CFP: 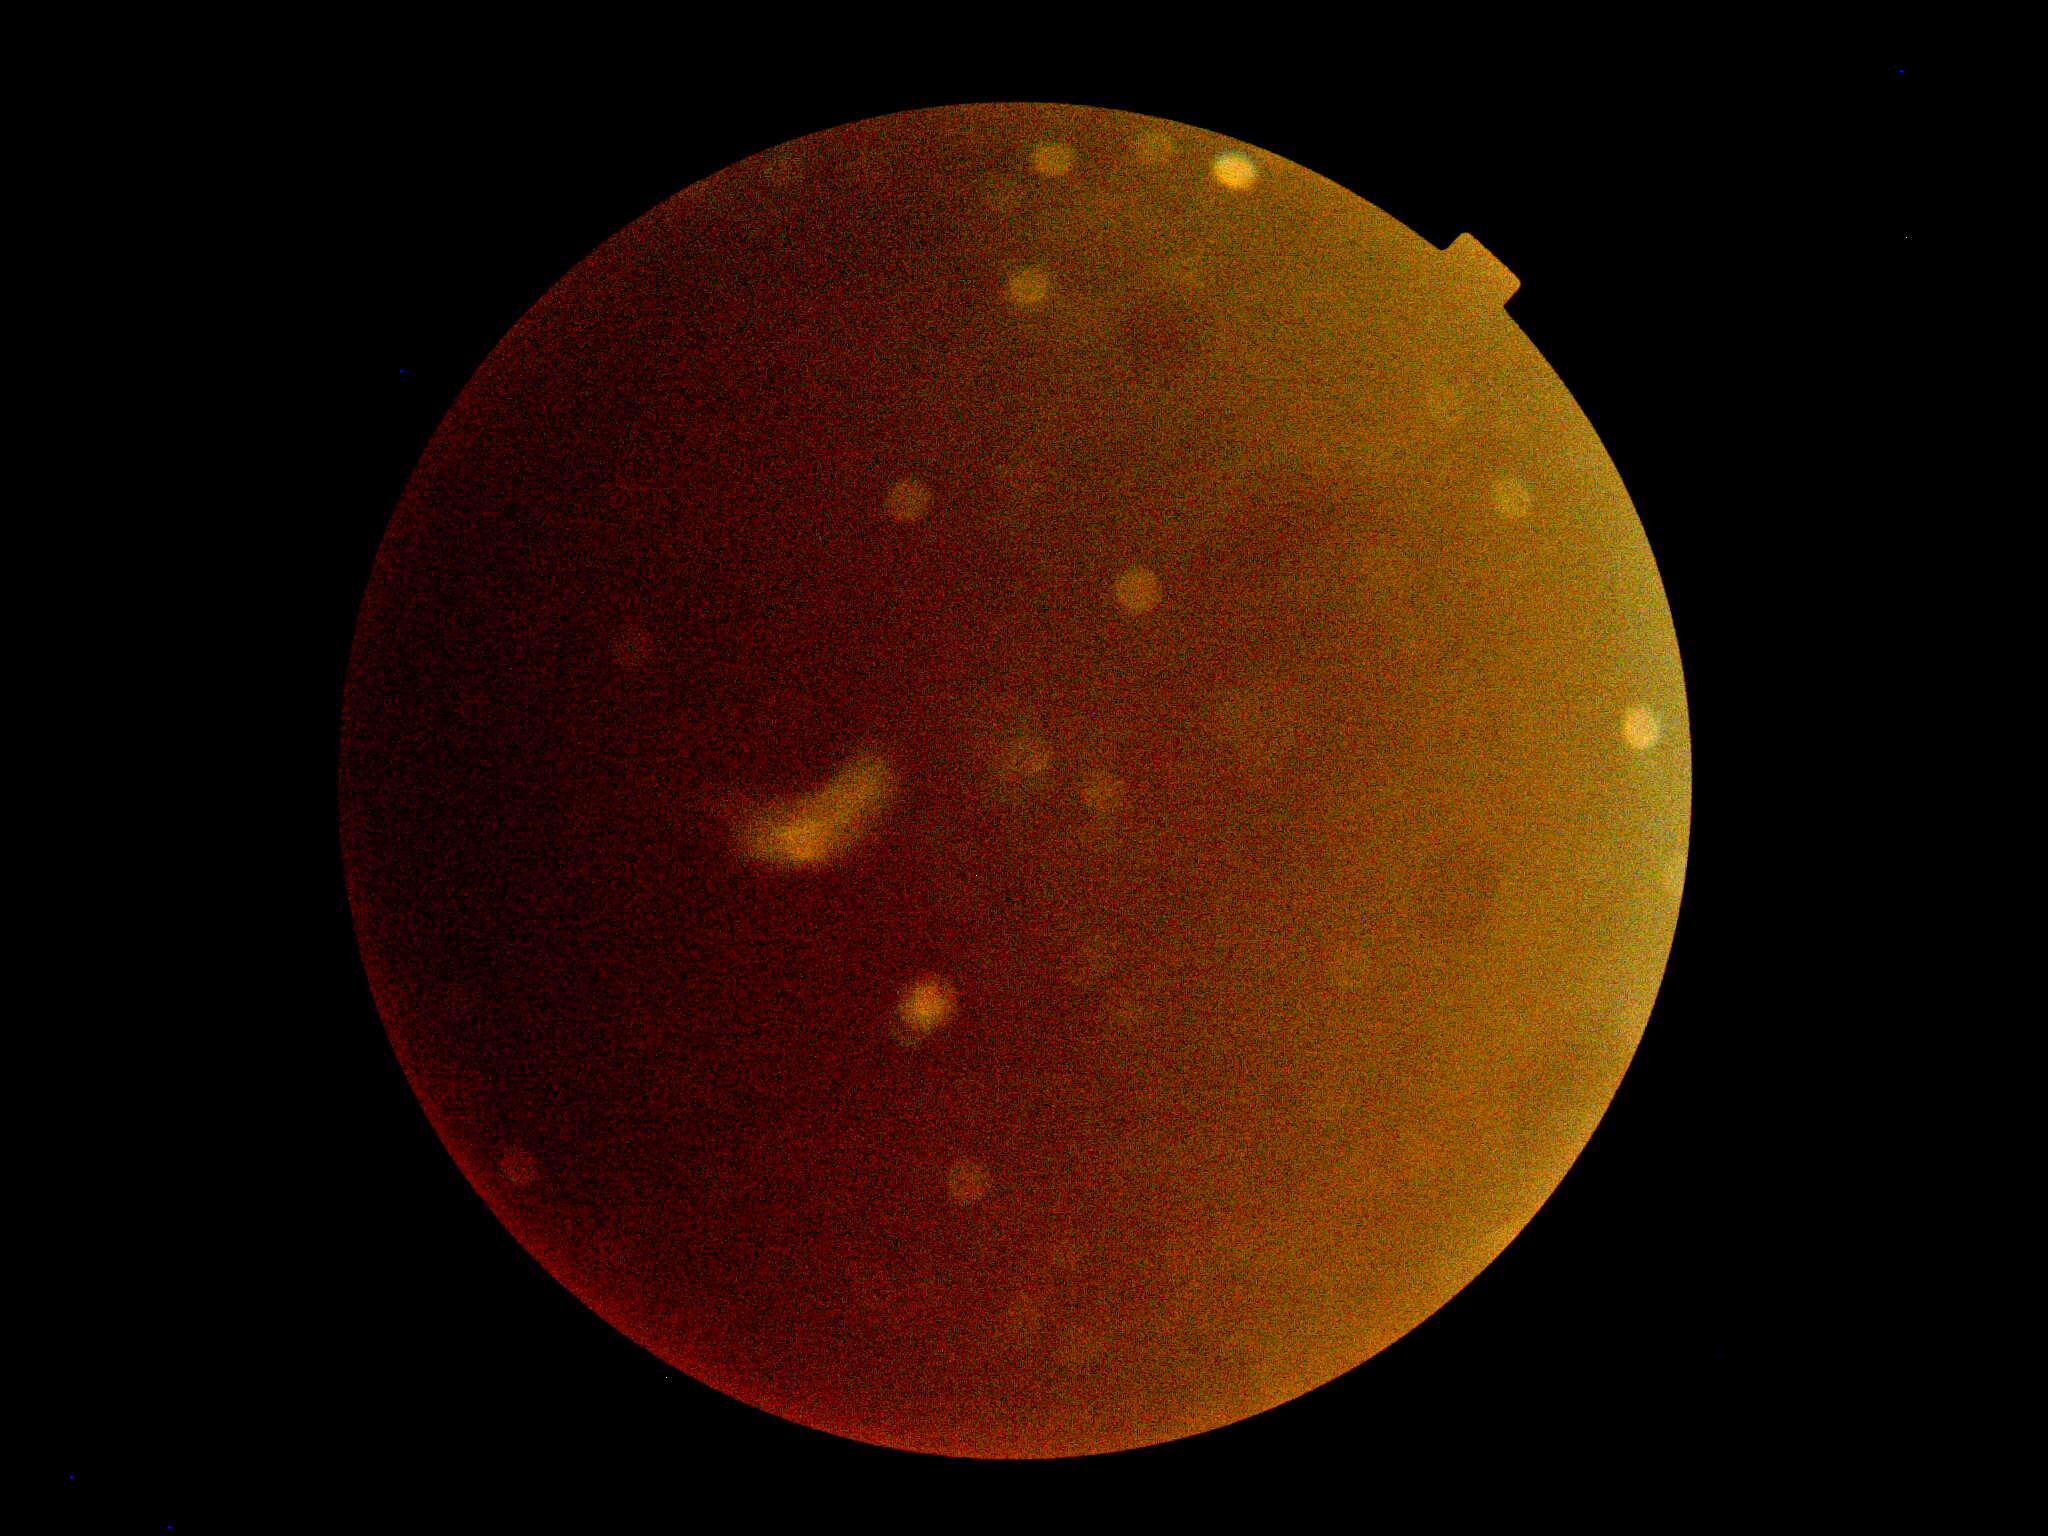

dr_grade: ungradable